Fundus photo. 1932x1916px: 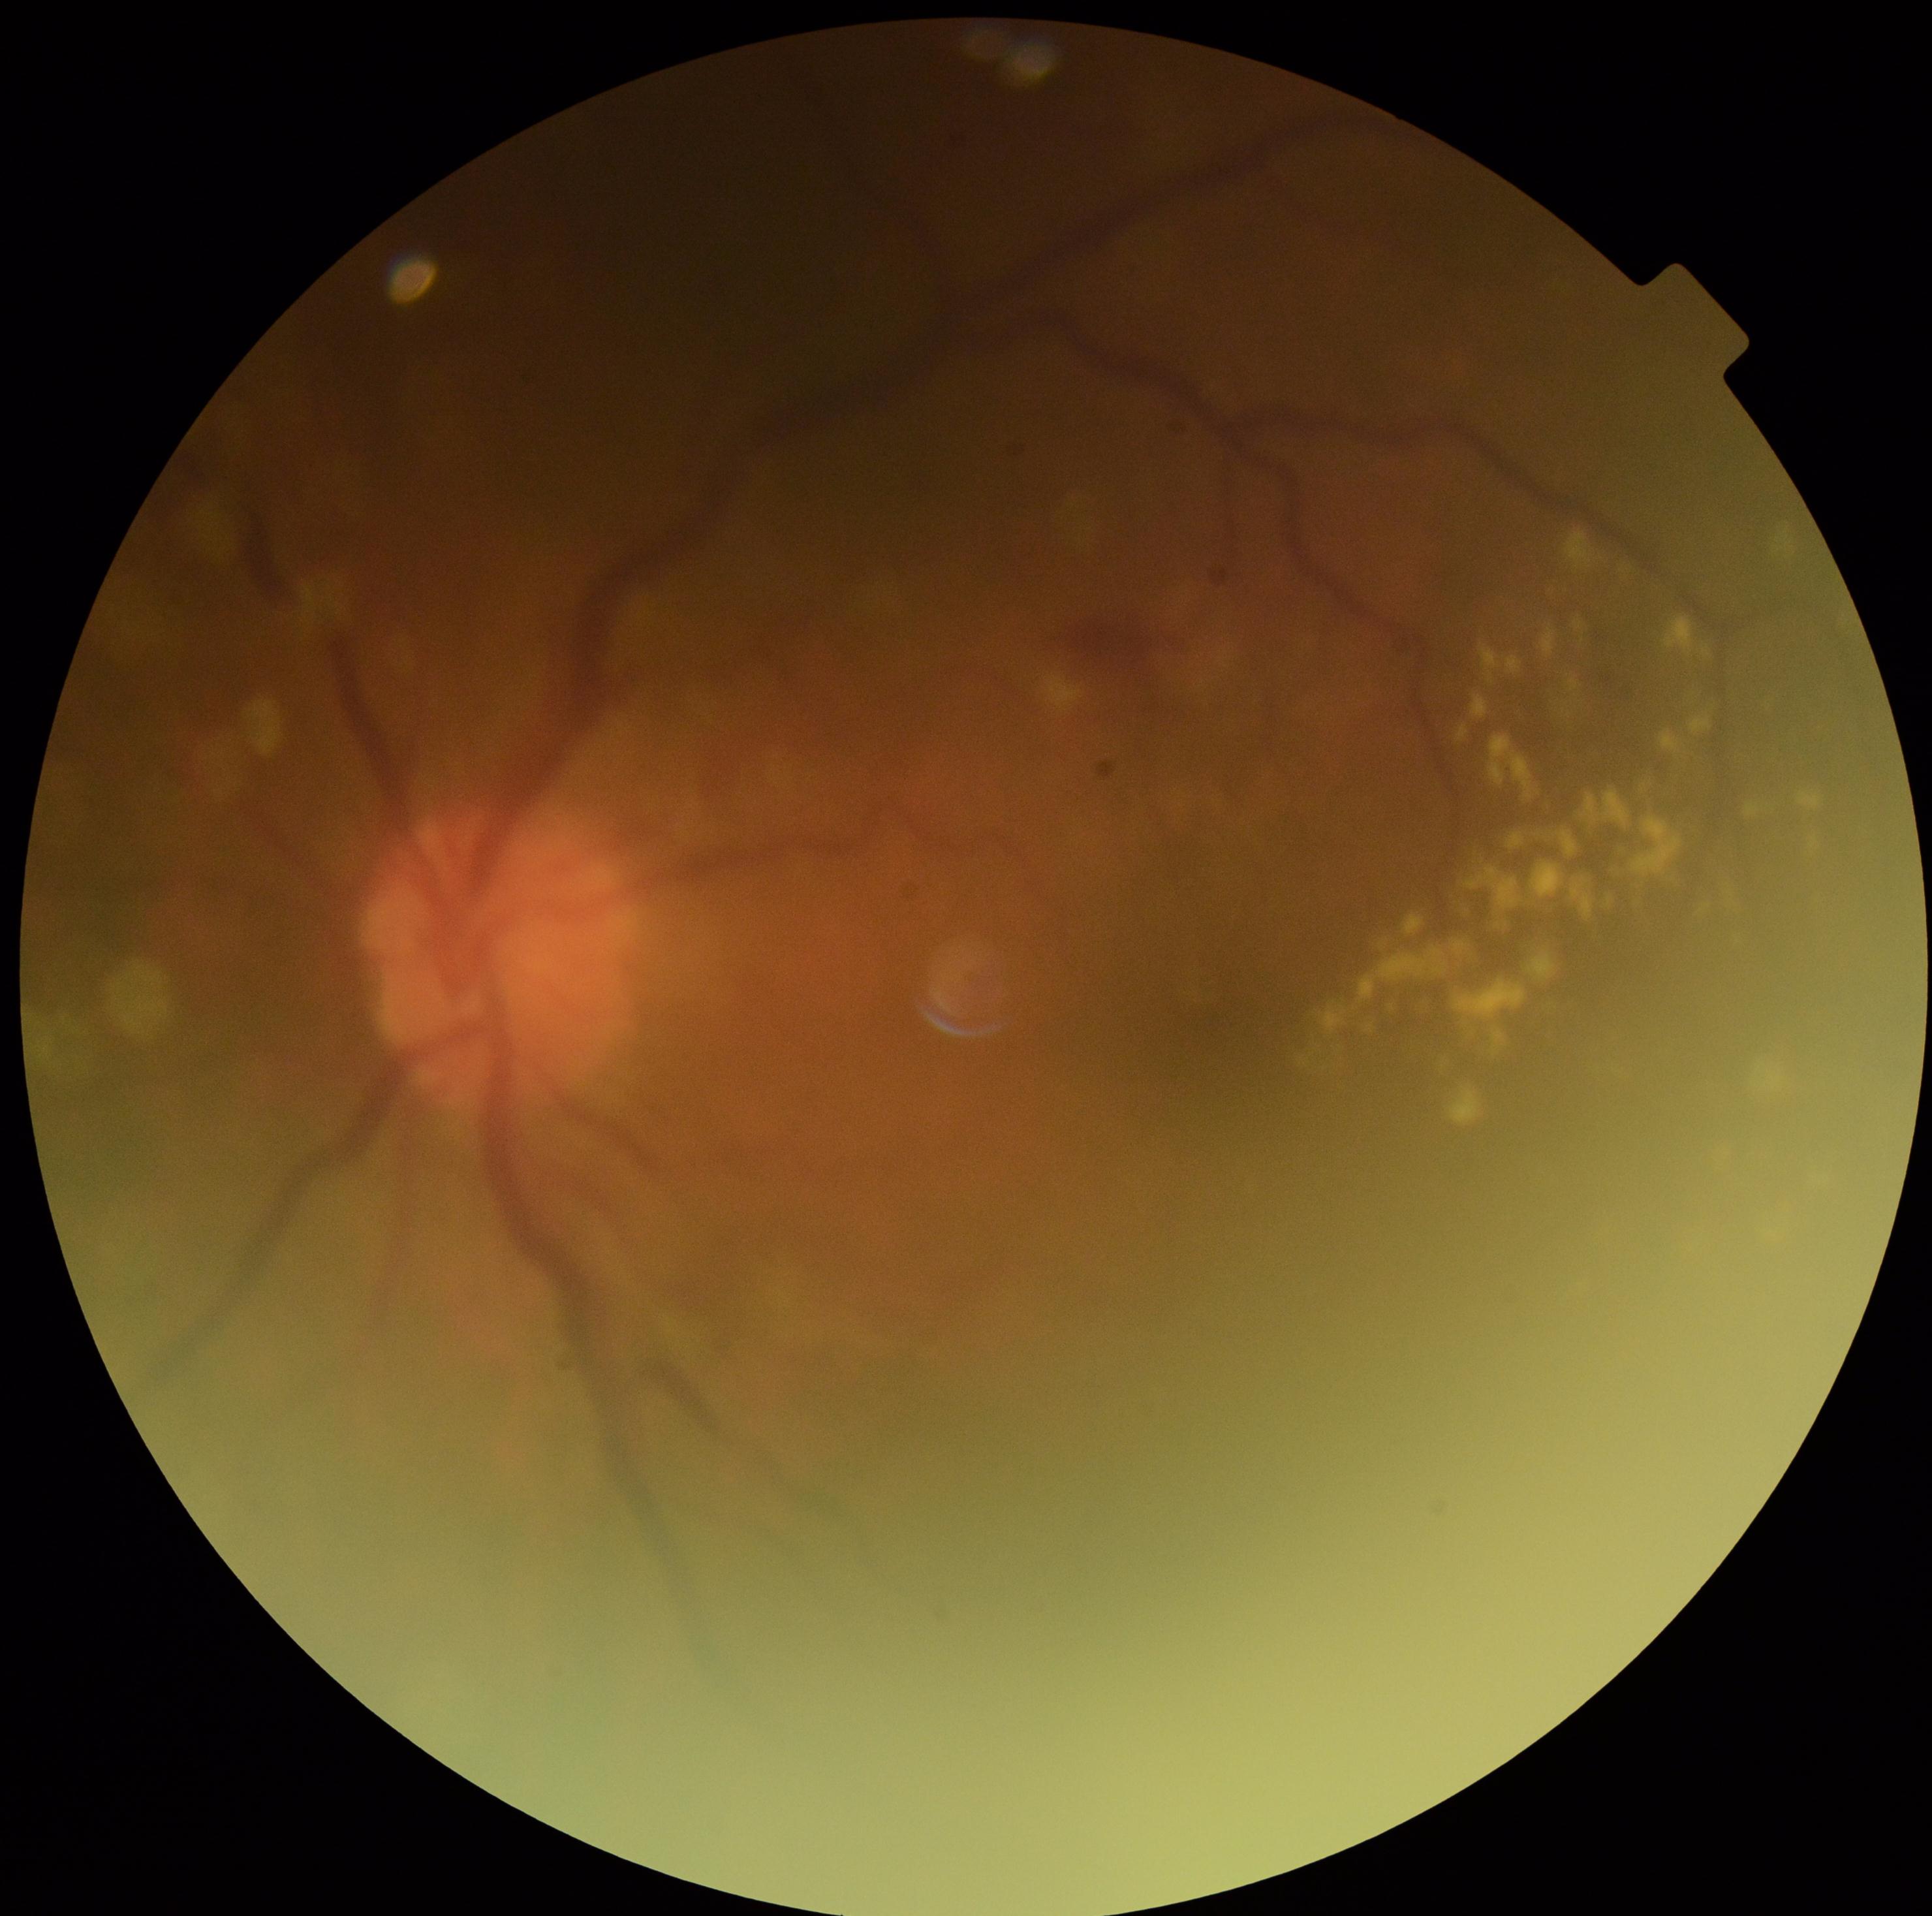
Diabetic retinopathy (DR) is 2 — more than just microaneurysms but less than severe NPDR.